45° field of view, image size 1932x1916:
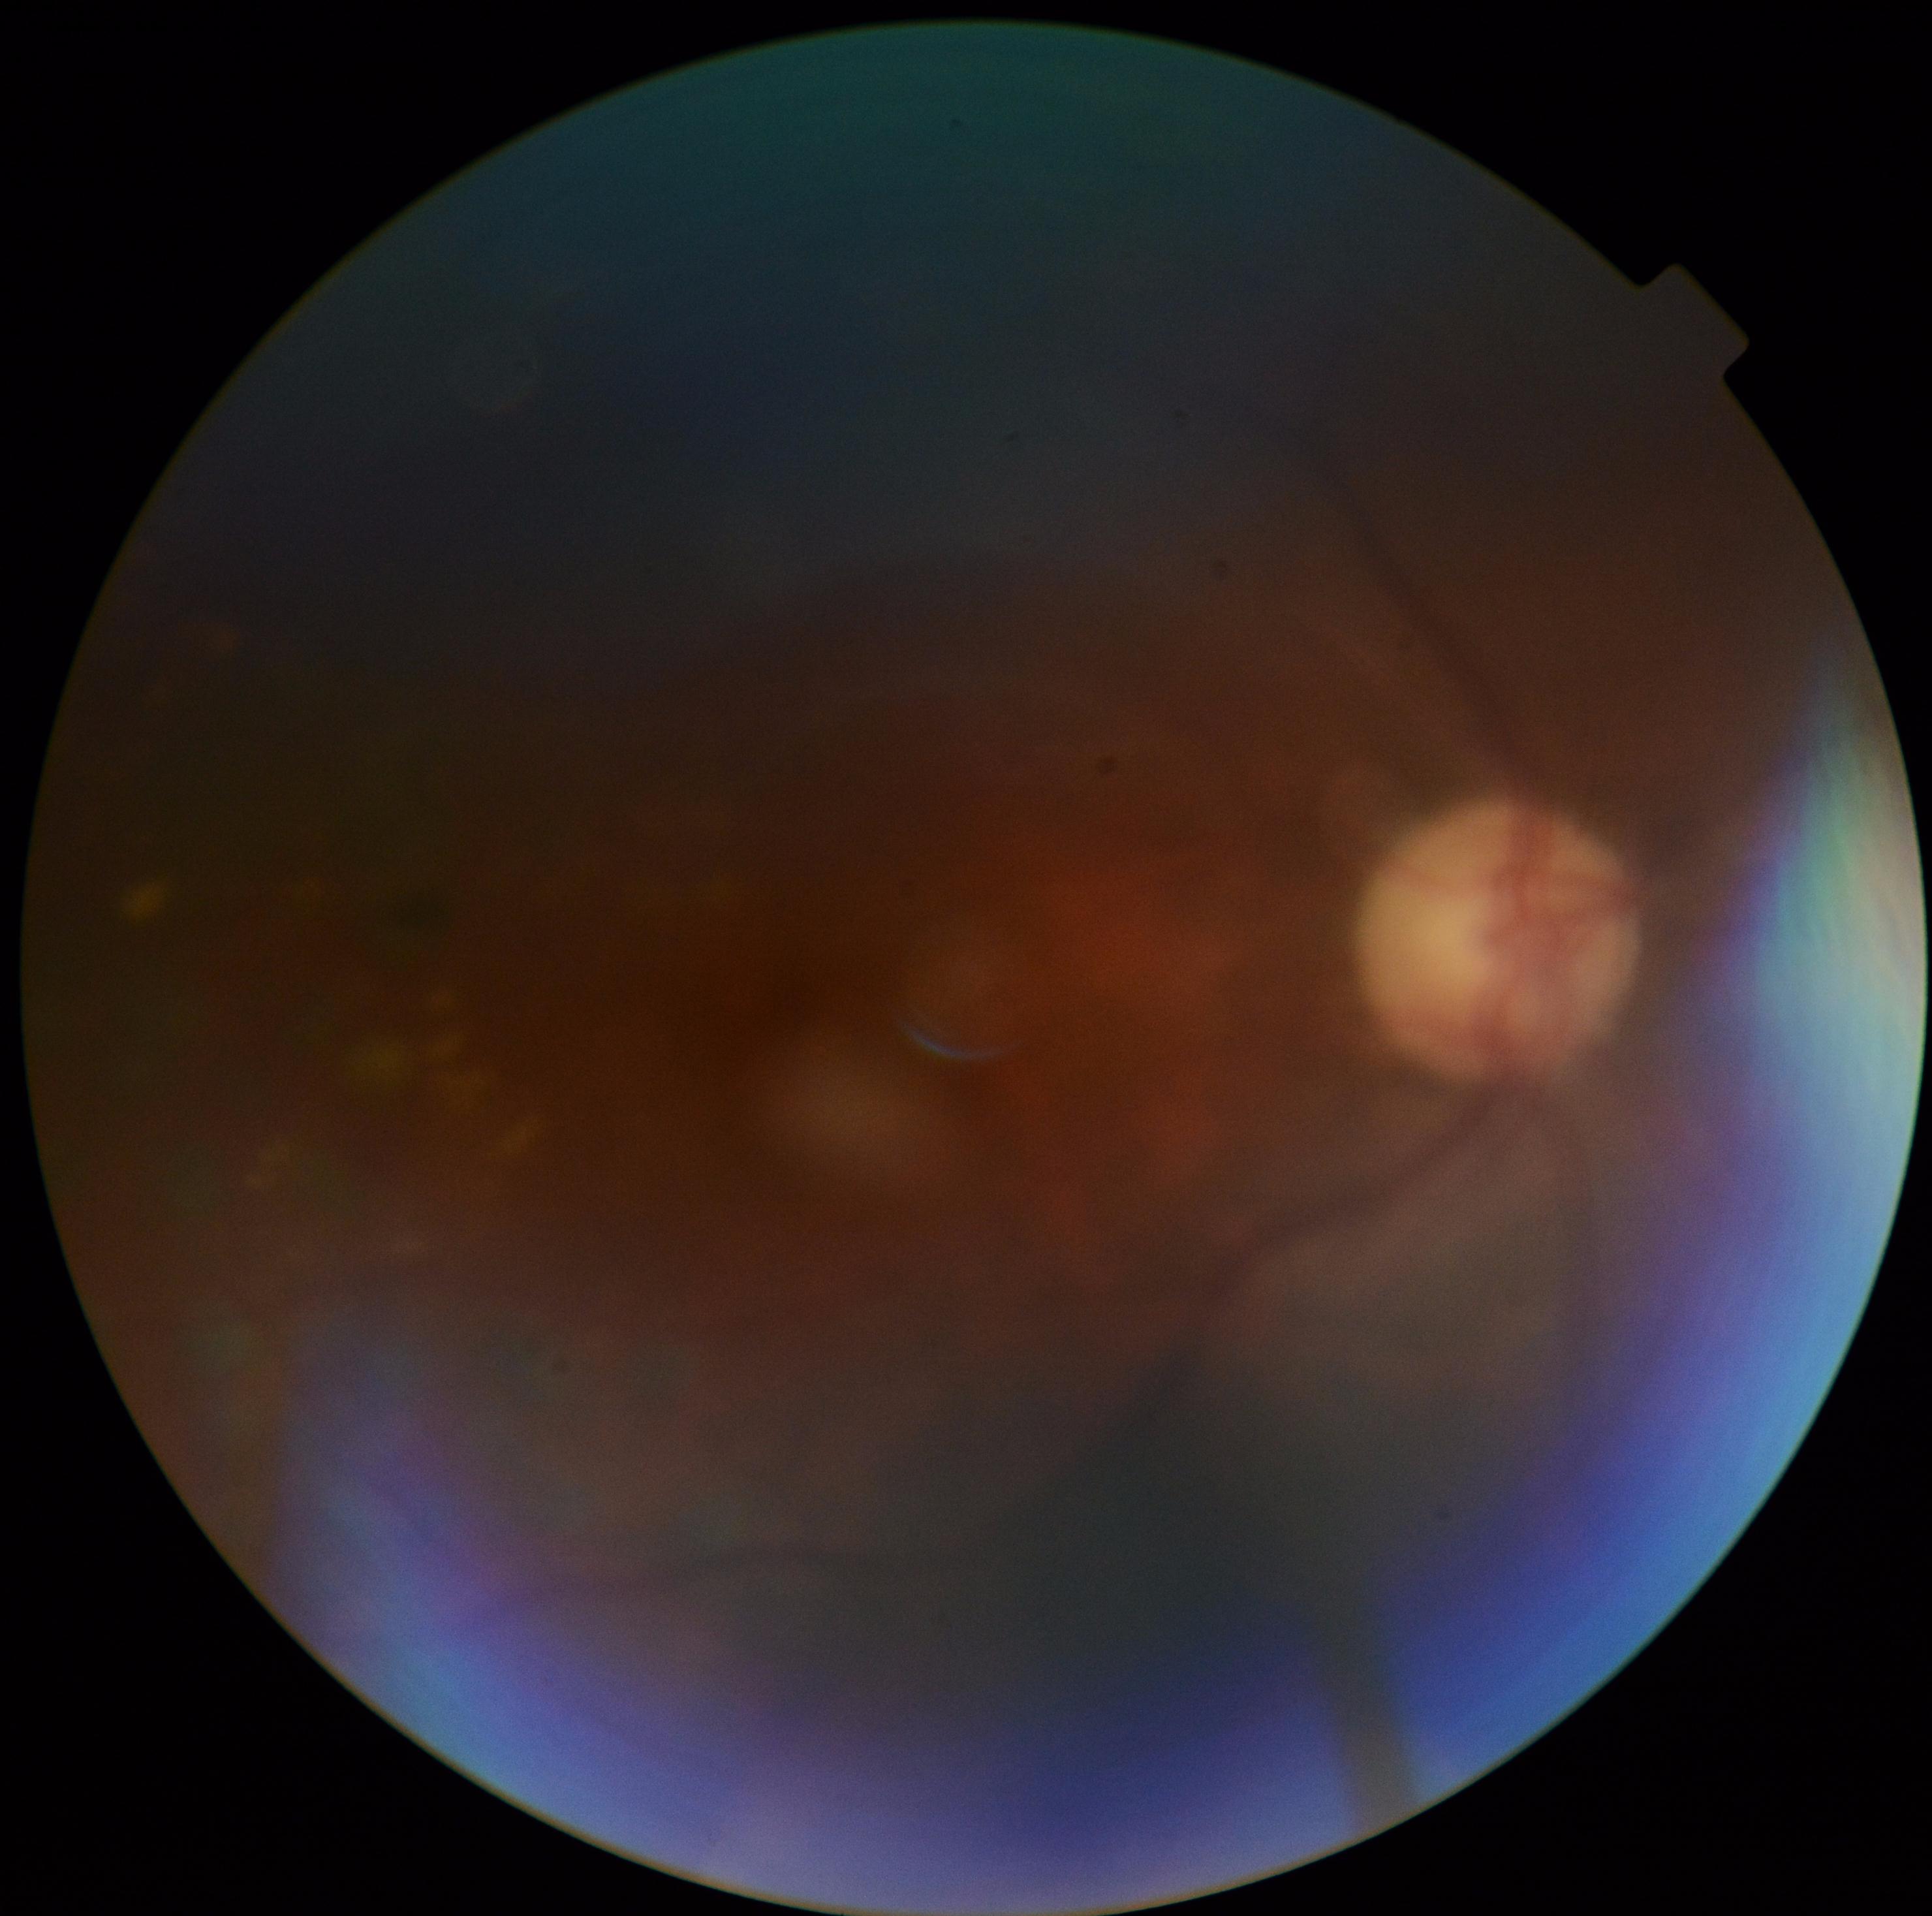 Diabetic retinopathy grade is 2 (moderate NPDR).